Color fundus photograph — 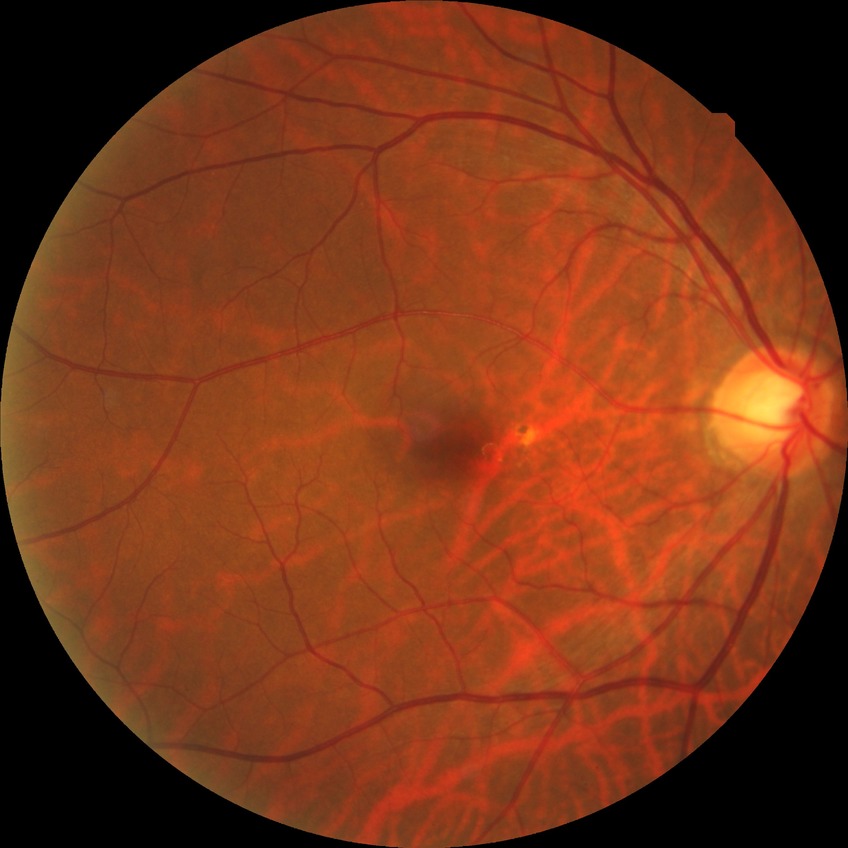 diabetic retinopathy (DR): NDR (no diabetic retinopathy)